DR severity per modified Davis staging · acquired with a NIDEK AFC-230
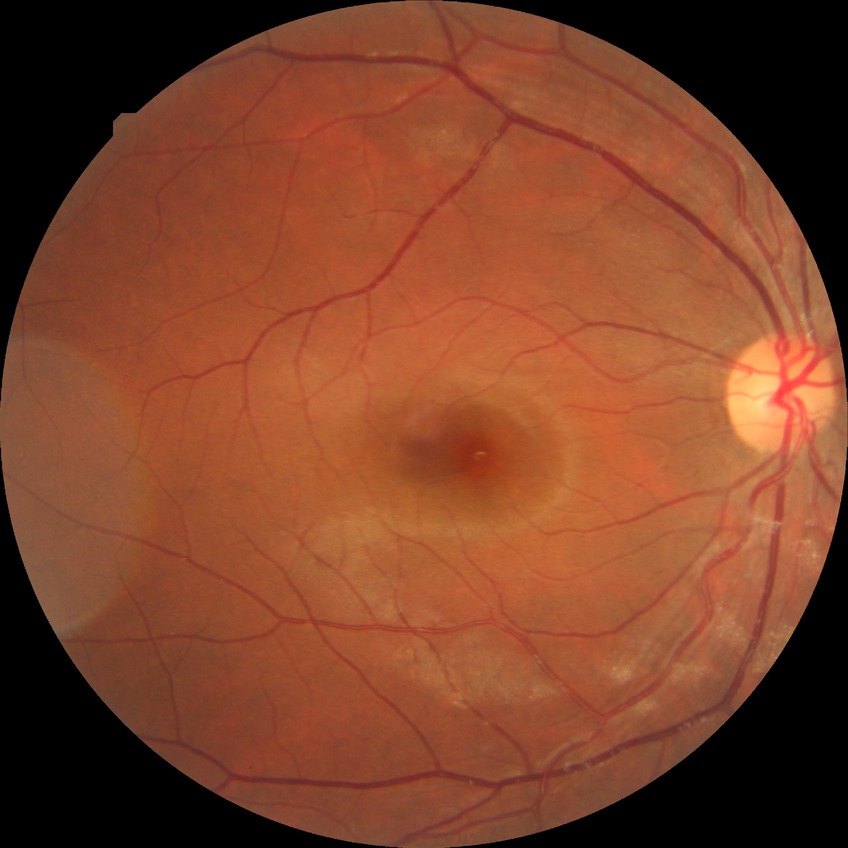

Modified Davis classification: no diabetic retinopathy.